Graded on the modified Davis scale; no pharmacologic dilation; 848 x 848 pixels
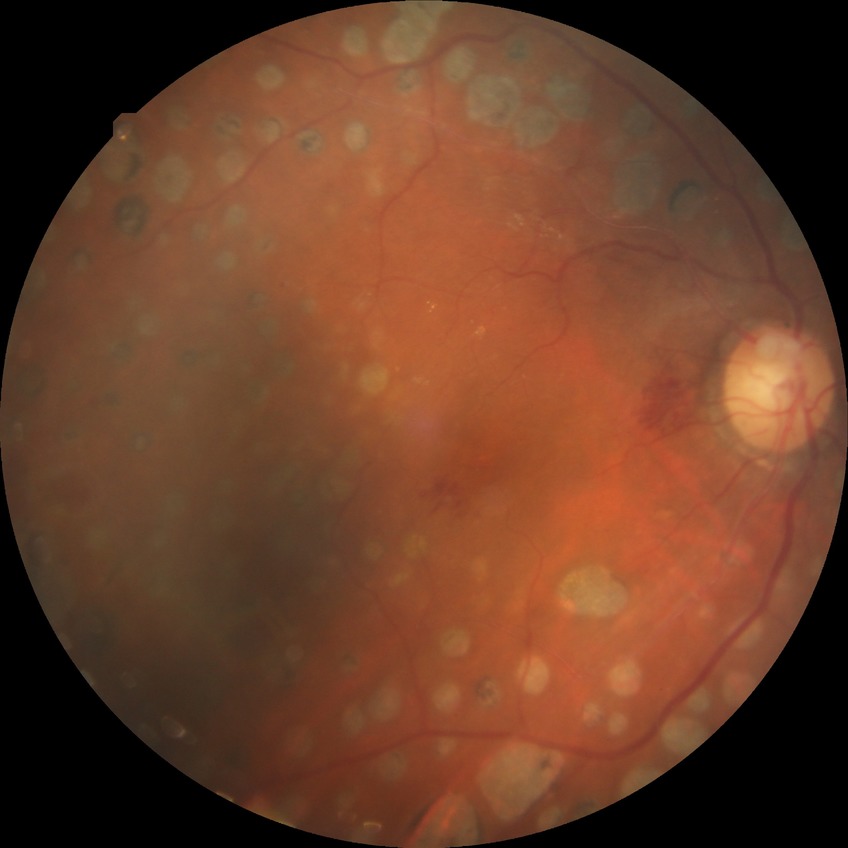 diabetic retinopathy grade=proliferative diabetic retinopathy.